CFP · dilated-pupil acquisition: 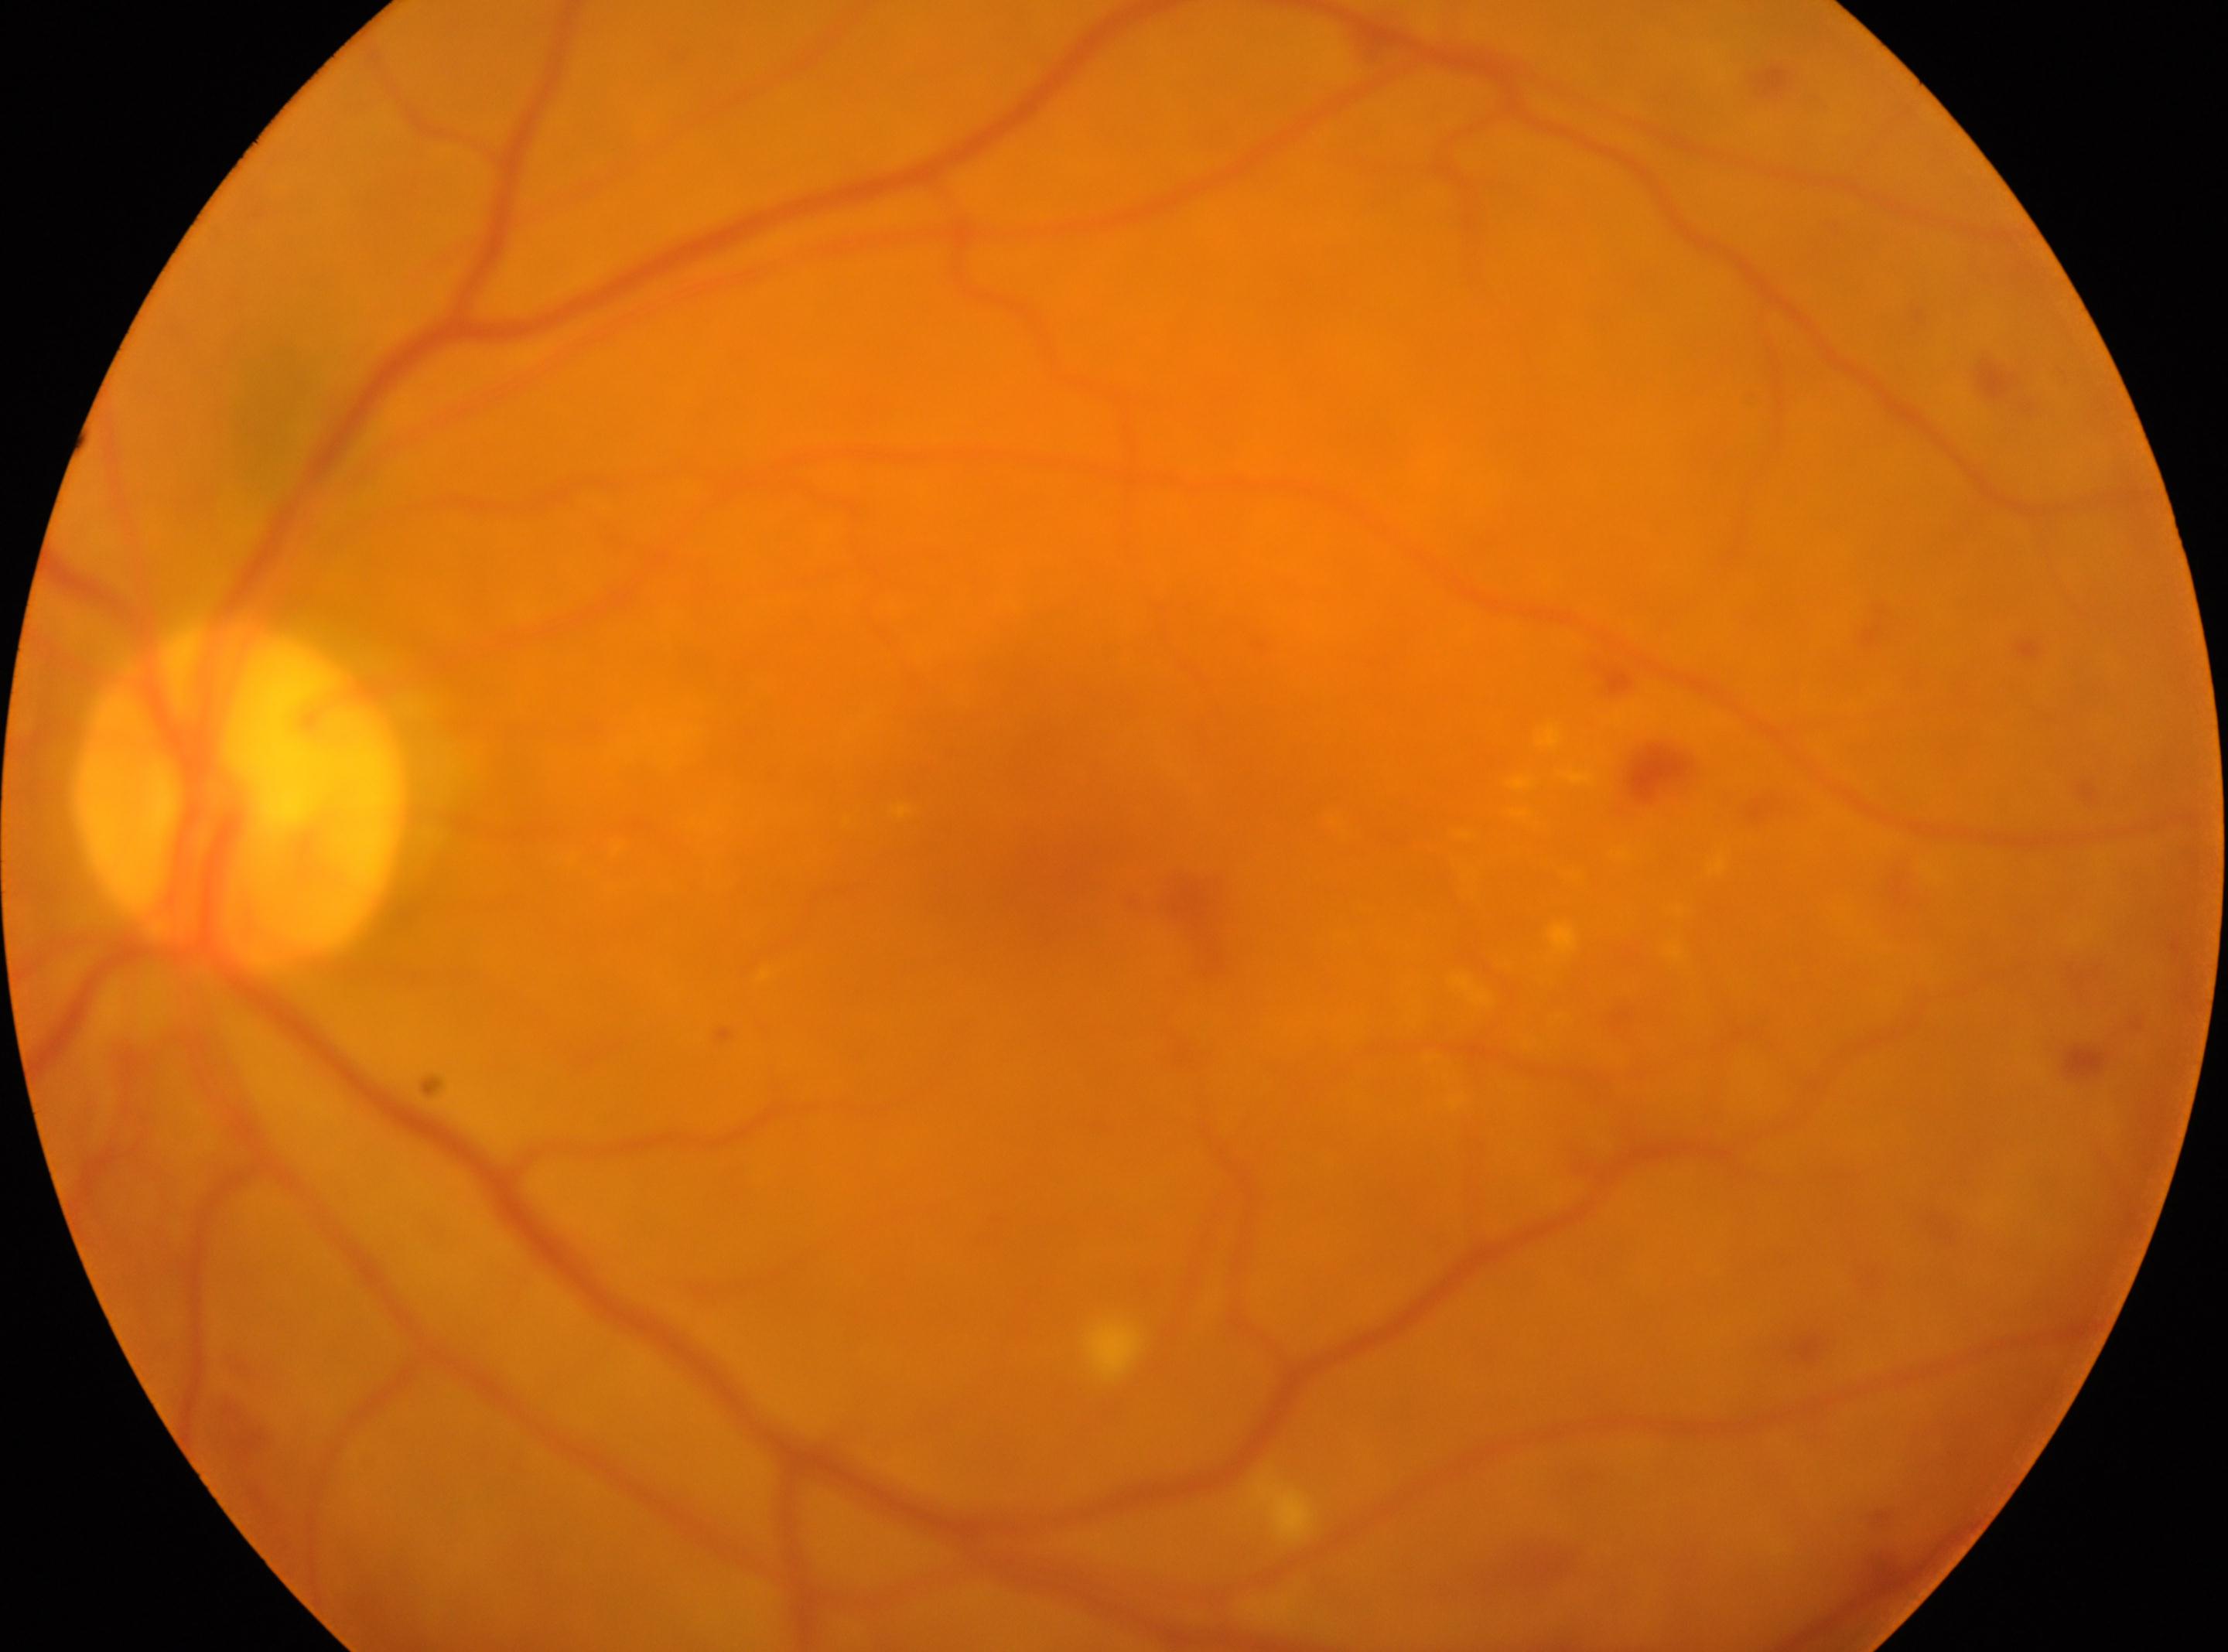 Diabetic retinopathy (DR): moderate NPDR (grade 2).
The macular center is at 1037, 812.
Optic disc located at 240, 795.
The image shows the oculus sinister.